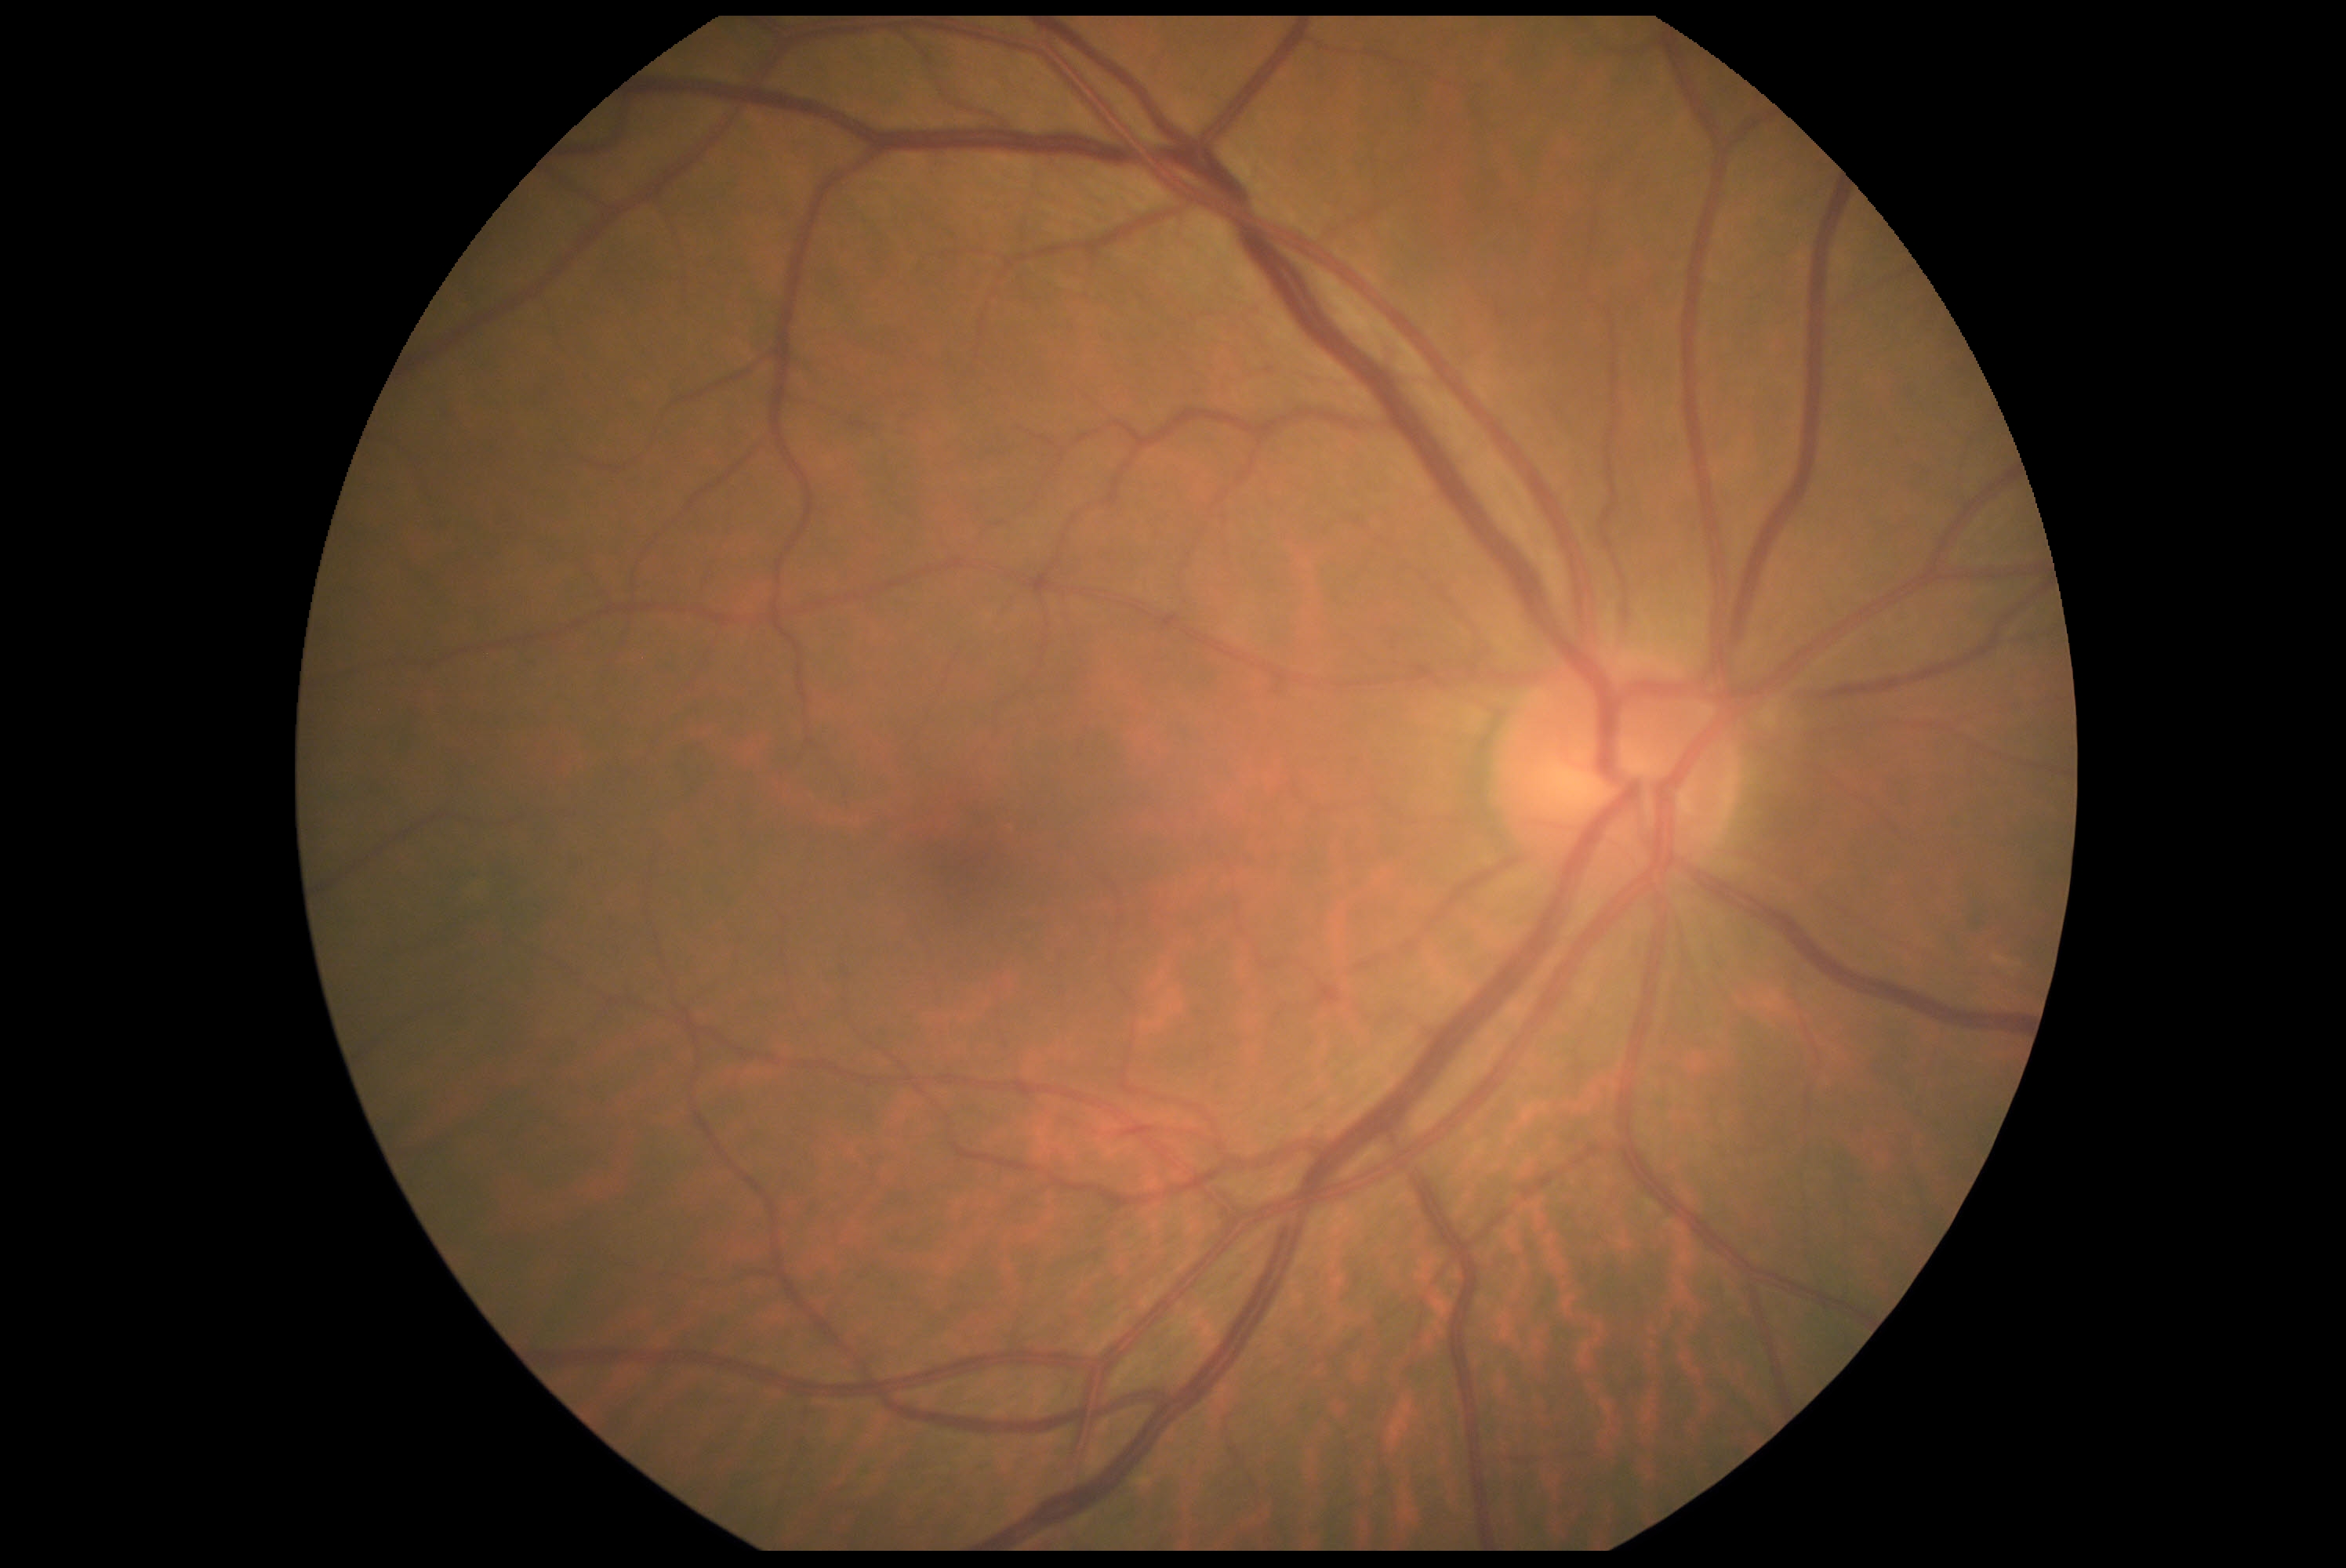 diabetic retinopathy (DR)=0.